Fundus photo. 512 x 512 pixels
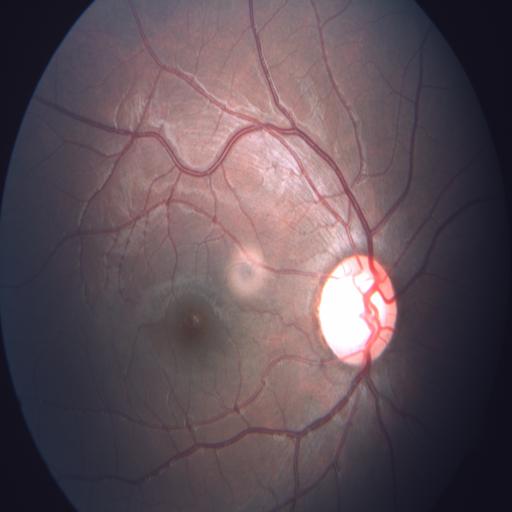
Demonstrates optic disc cupping.